1440 x 1080 pixels; pediatric wide-field fundus photograph: 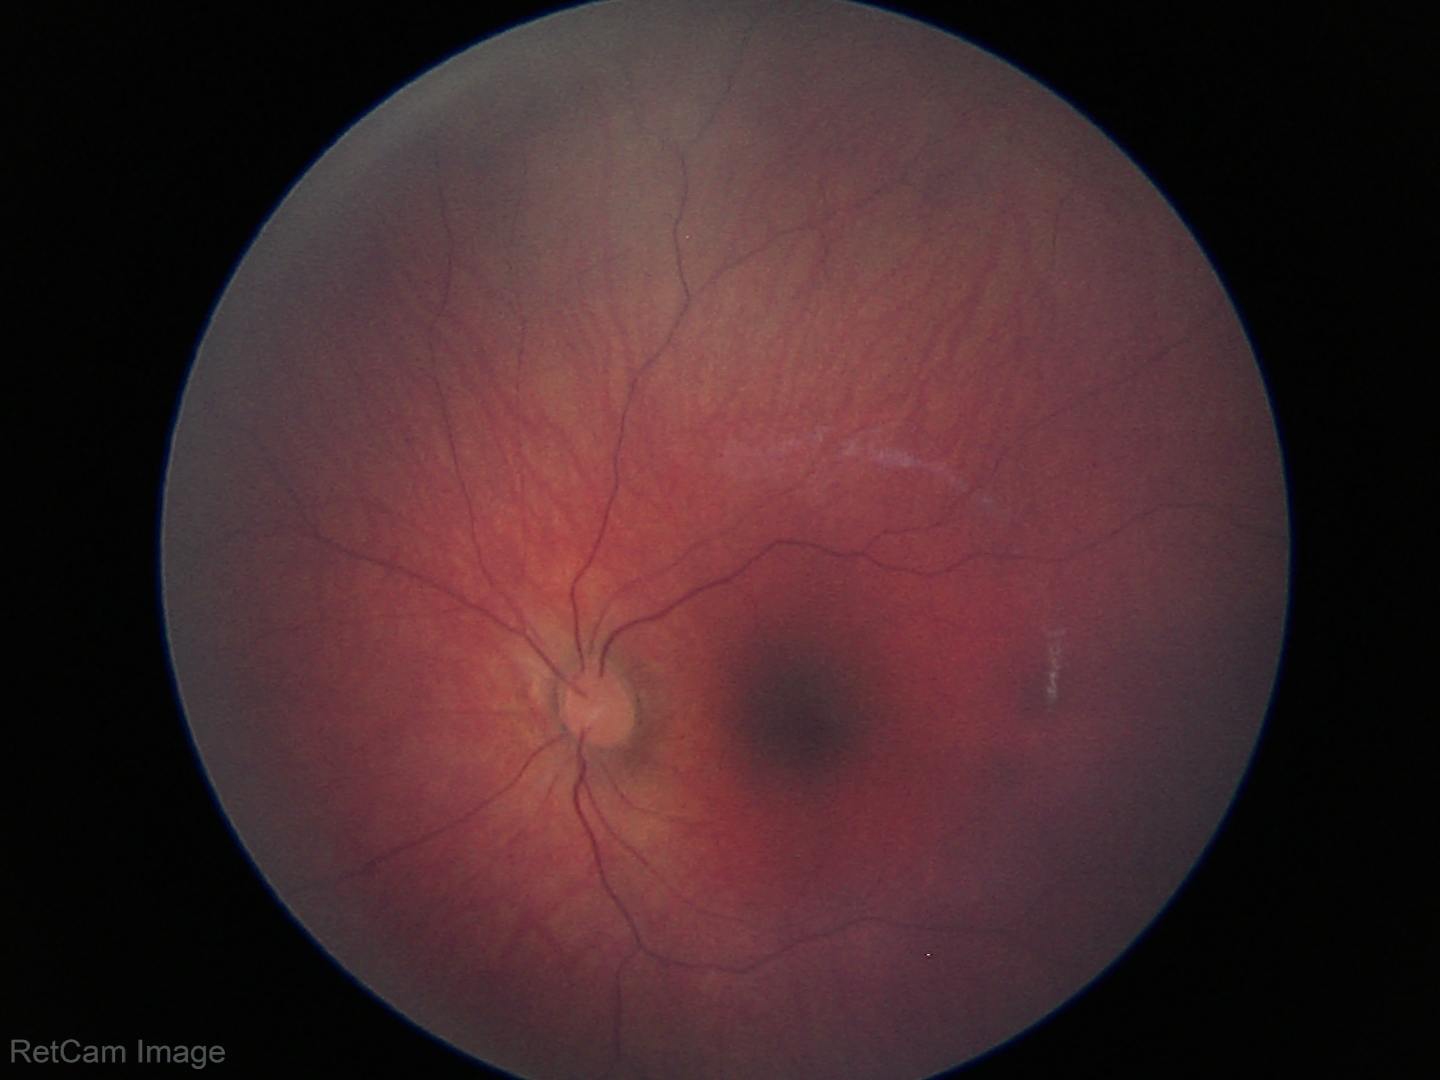 Screening examination with no abnormal retinal findings.